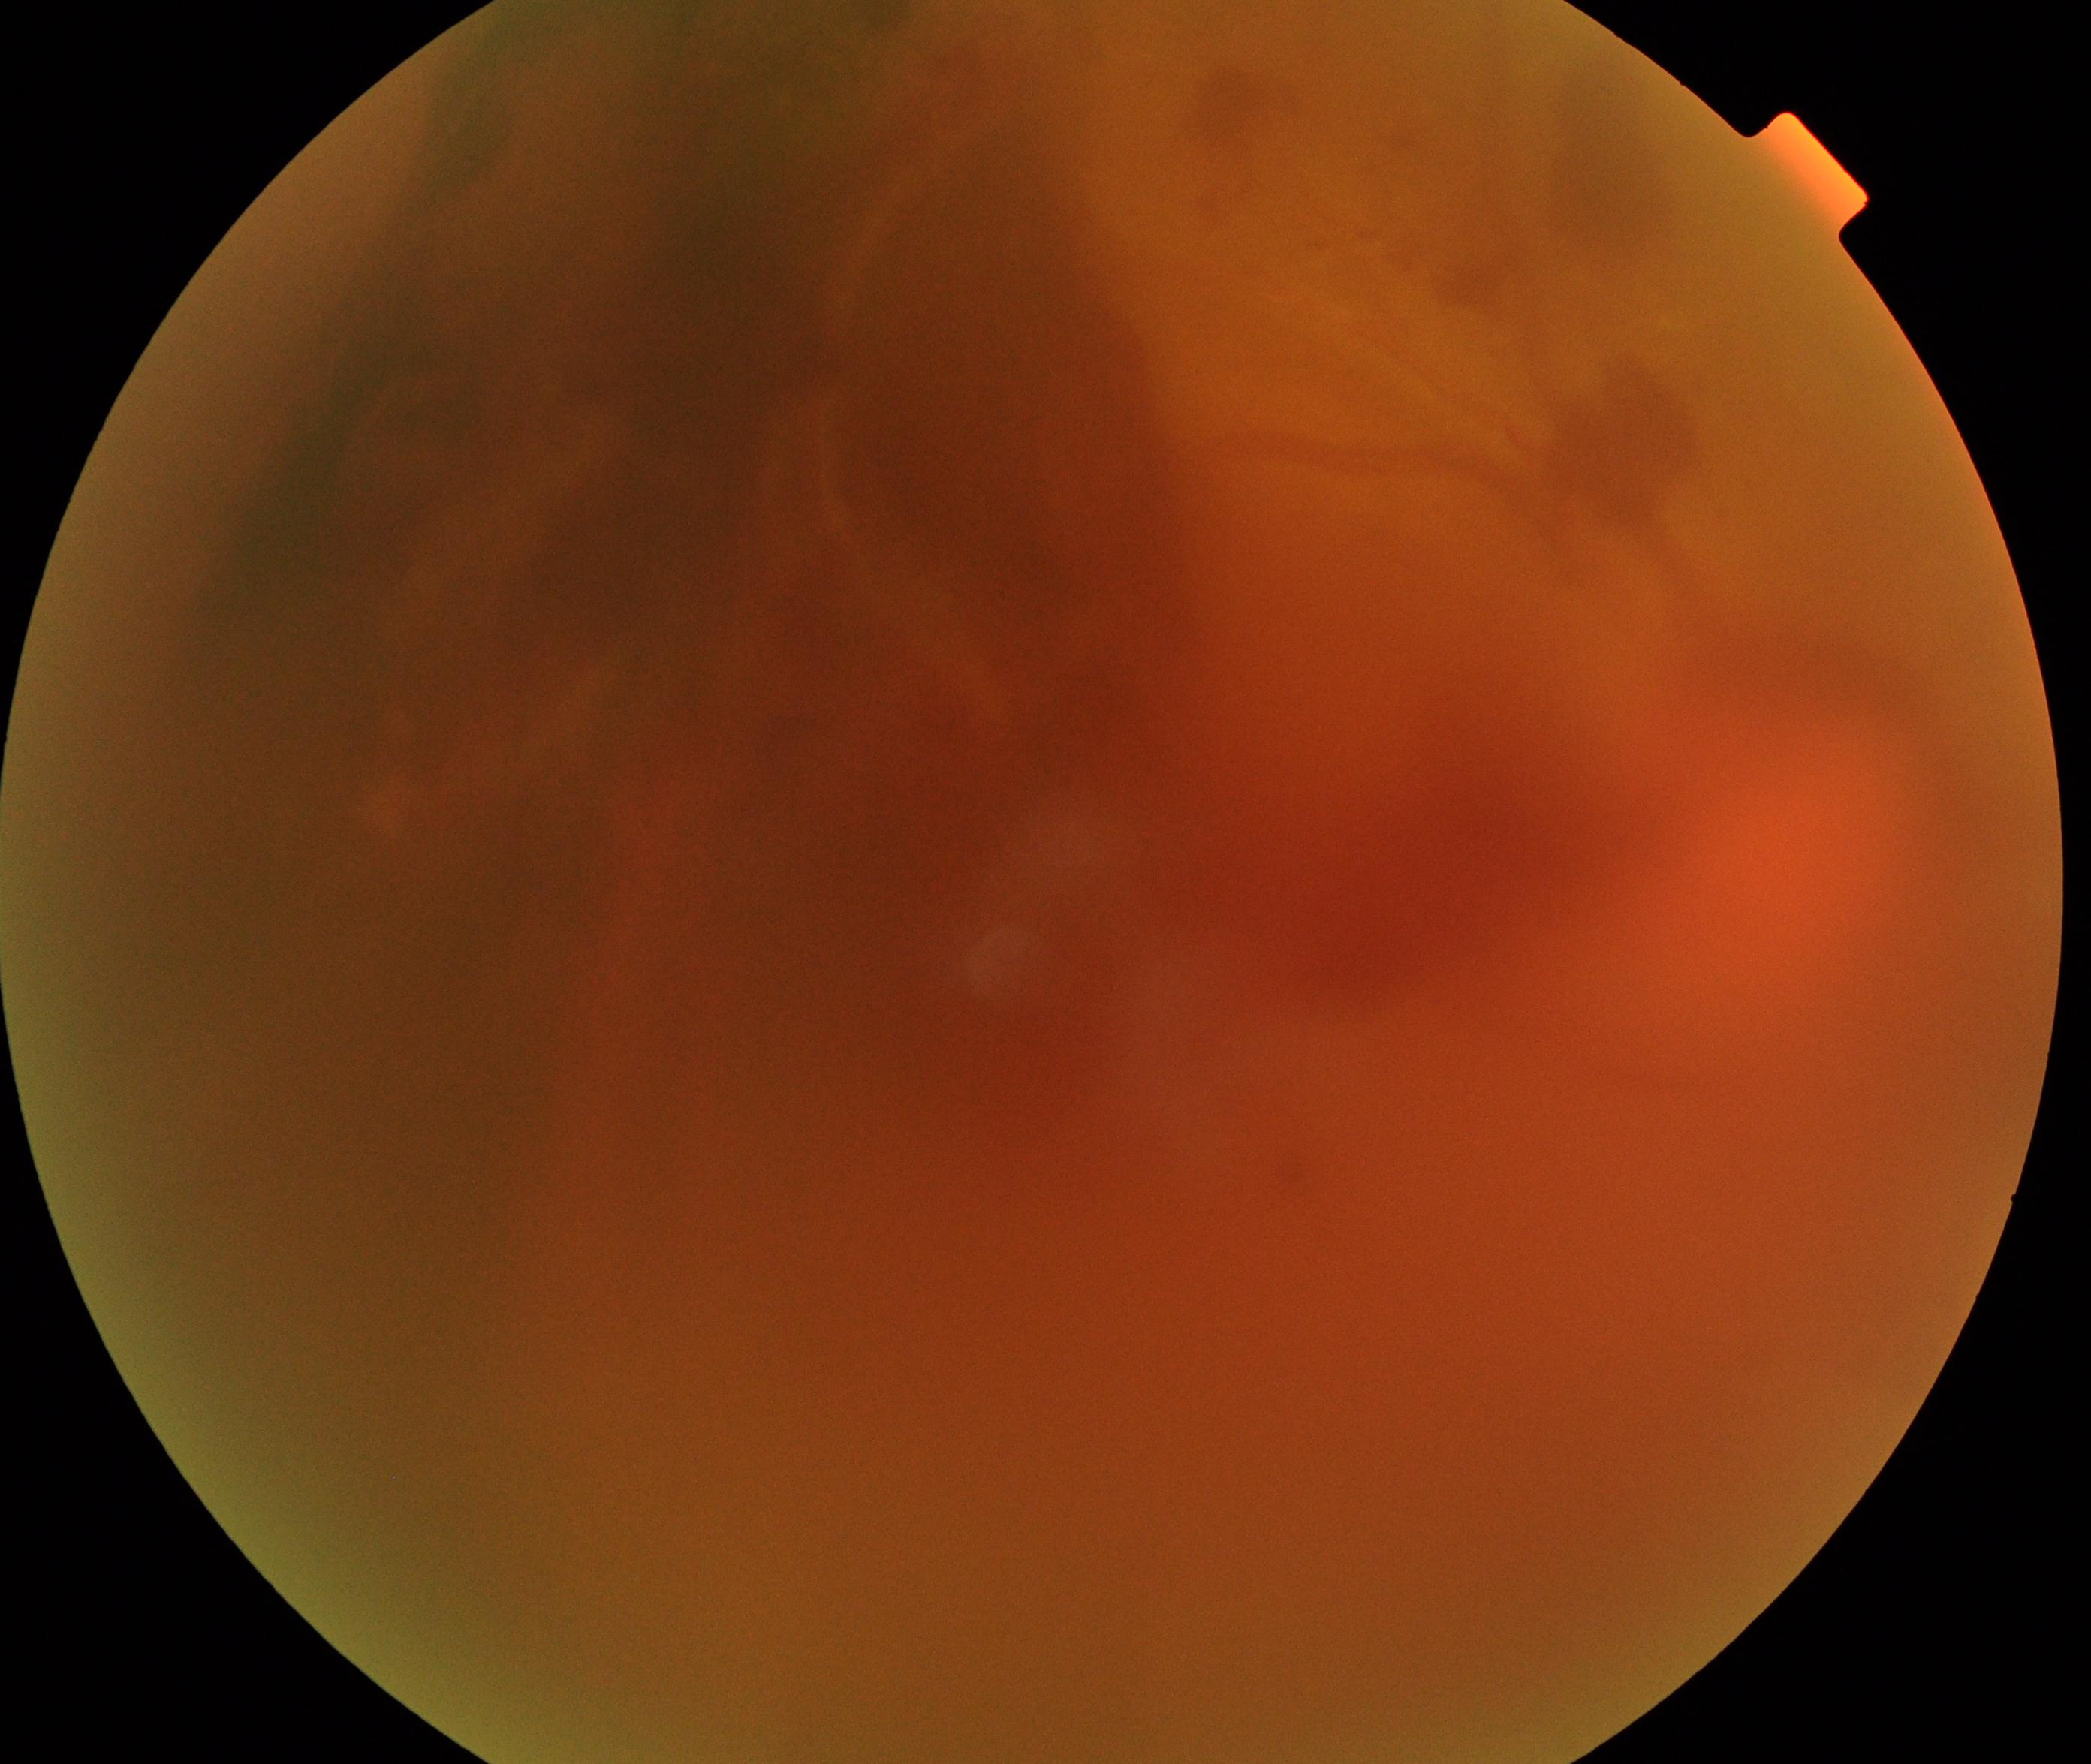
Image quality: poor. Proliferative diabetic retinopathy: suspected.